2352x1568; FOV: 45 degrees
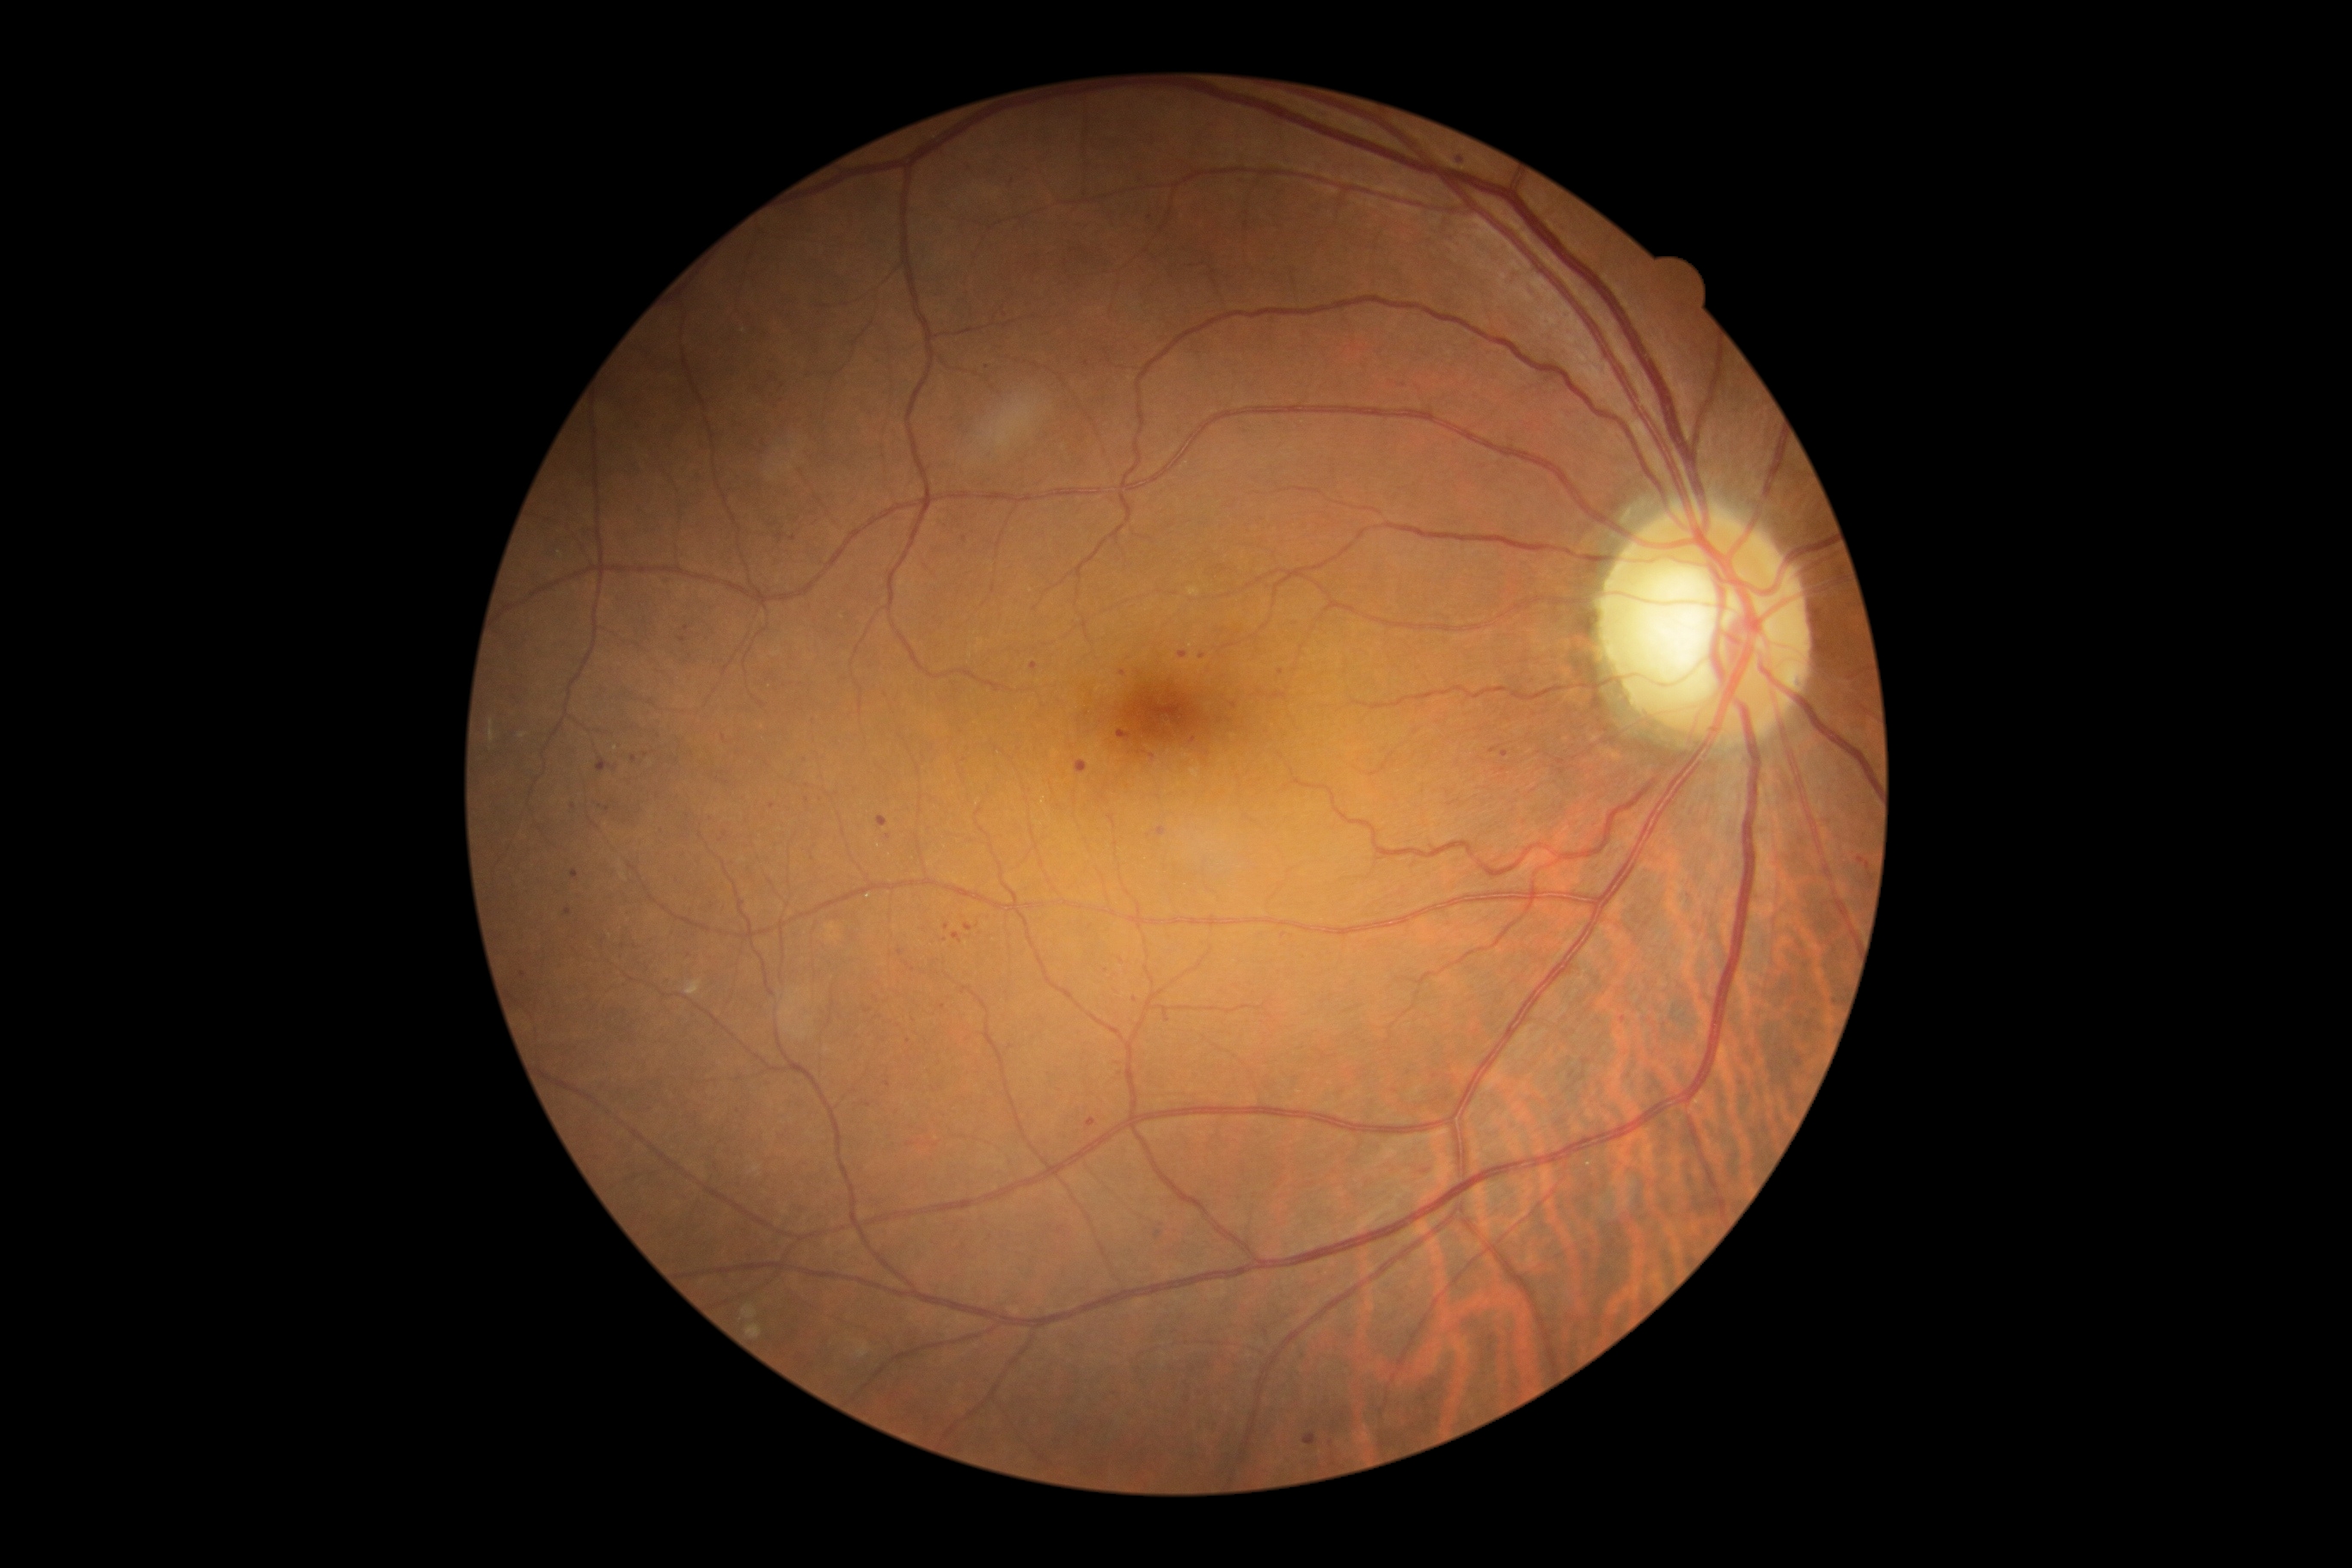 <lesions partial="true">
  <dr_grade>1</dr_grade>
  <ex />
  <ma partial="true">[left=1031, top=663, right=1038, bottom=671]; [left=596, top=764, right=604, bottom=771]; [left=1086, top=1118, right=1098, bottom=1129]; [left=1075, top=761, right=1089, bottom=775]</ma>
  <ma_small>x=724, y=835; x=1230, y=721; x=772, y=806; x=964, y=539; x=1091, y=927; x=1281, y=672; x=1623, y=1020; x=888, y=1084; x=568, y=912; x=821, y=800; x=608, y=810; x=1836, y=1002; x=946, y=927</ma_small>
  <se />
  <he />
</lesions>